Diabetic retinopathy graded by the modified Davis classification. 848 by 848 pixels
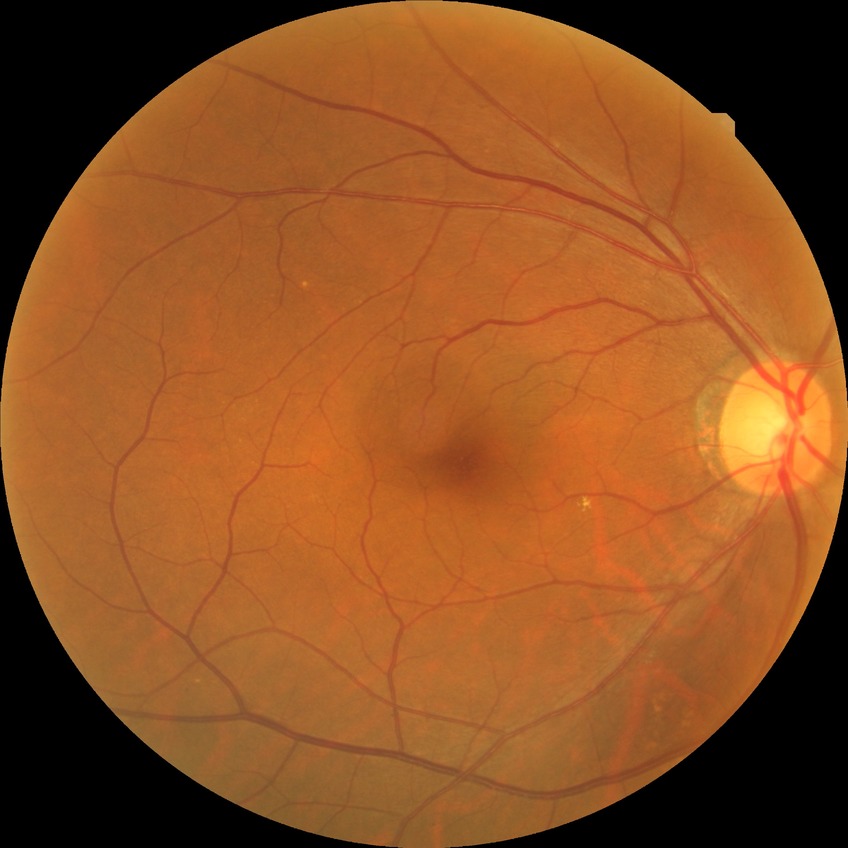

retinopathy grade: no diabetic retinopathy.